1240 x 1240 pixels. Infant wide-field fundus photograph. Acquired on the Phoenix ICON
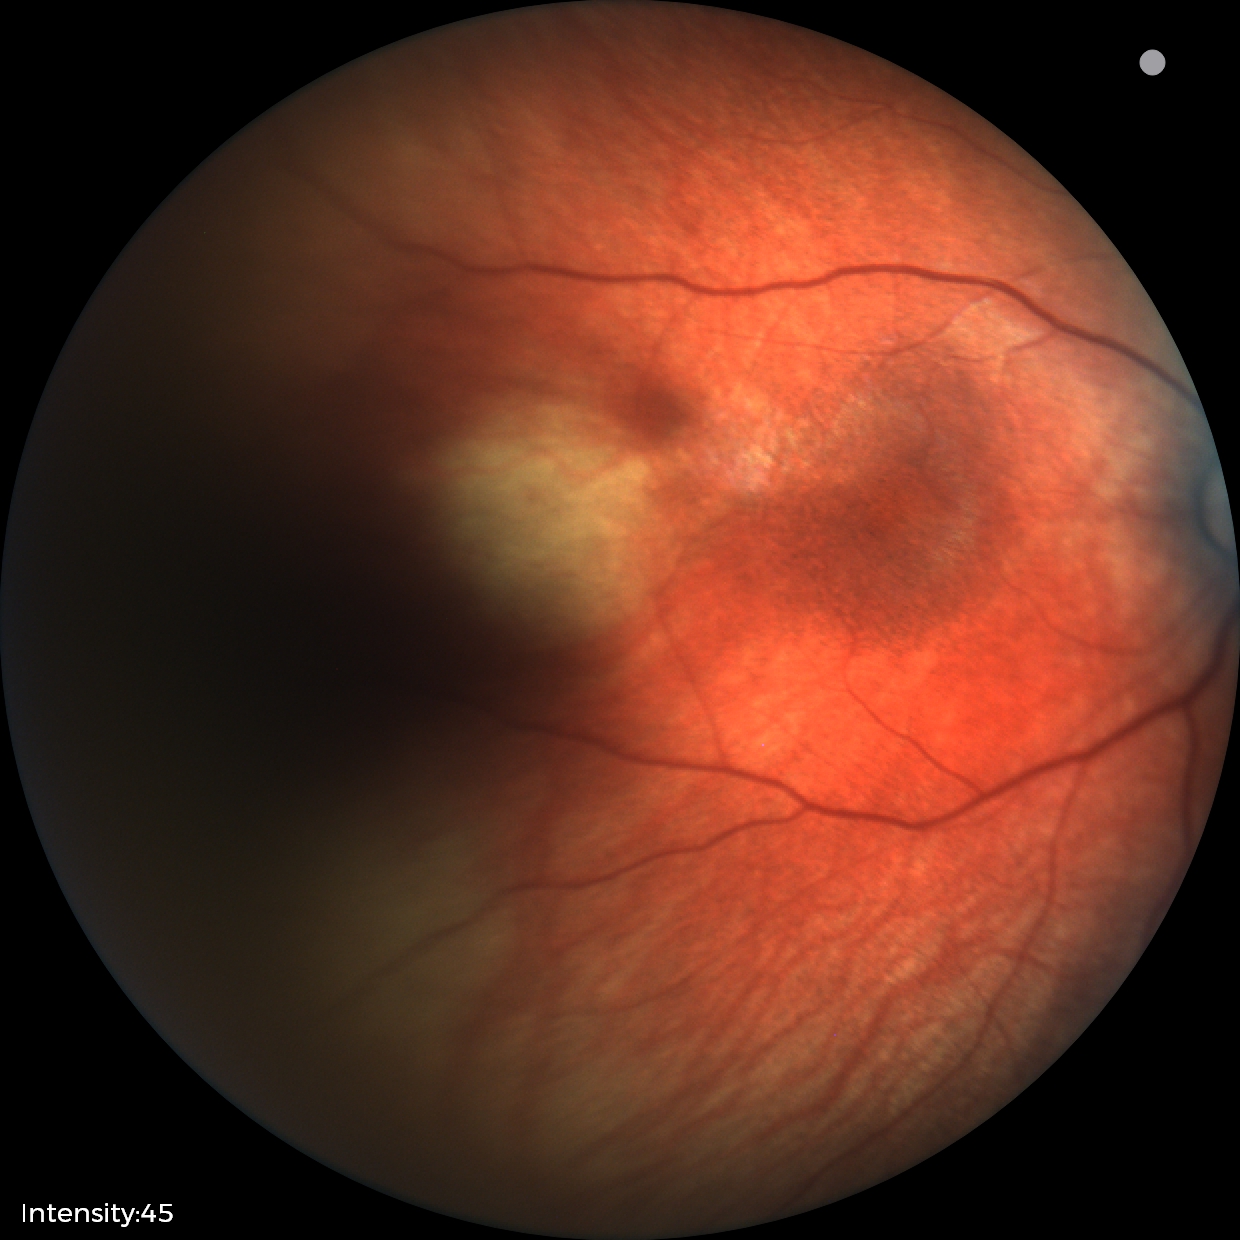 Diagnosis: physiological